Image size 1924x1556. Wide-field retinal mosaic image
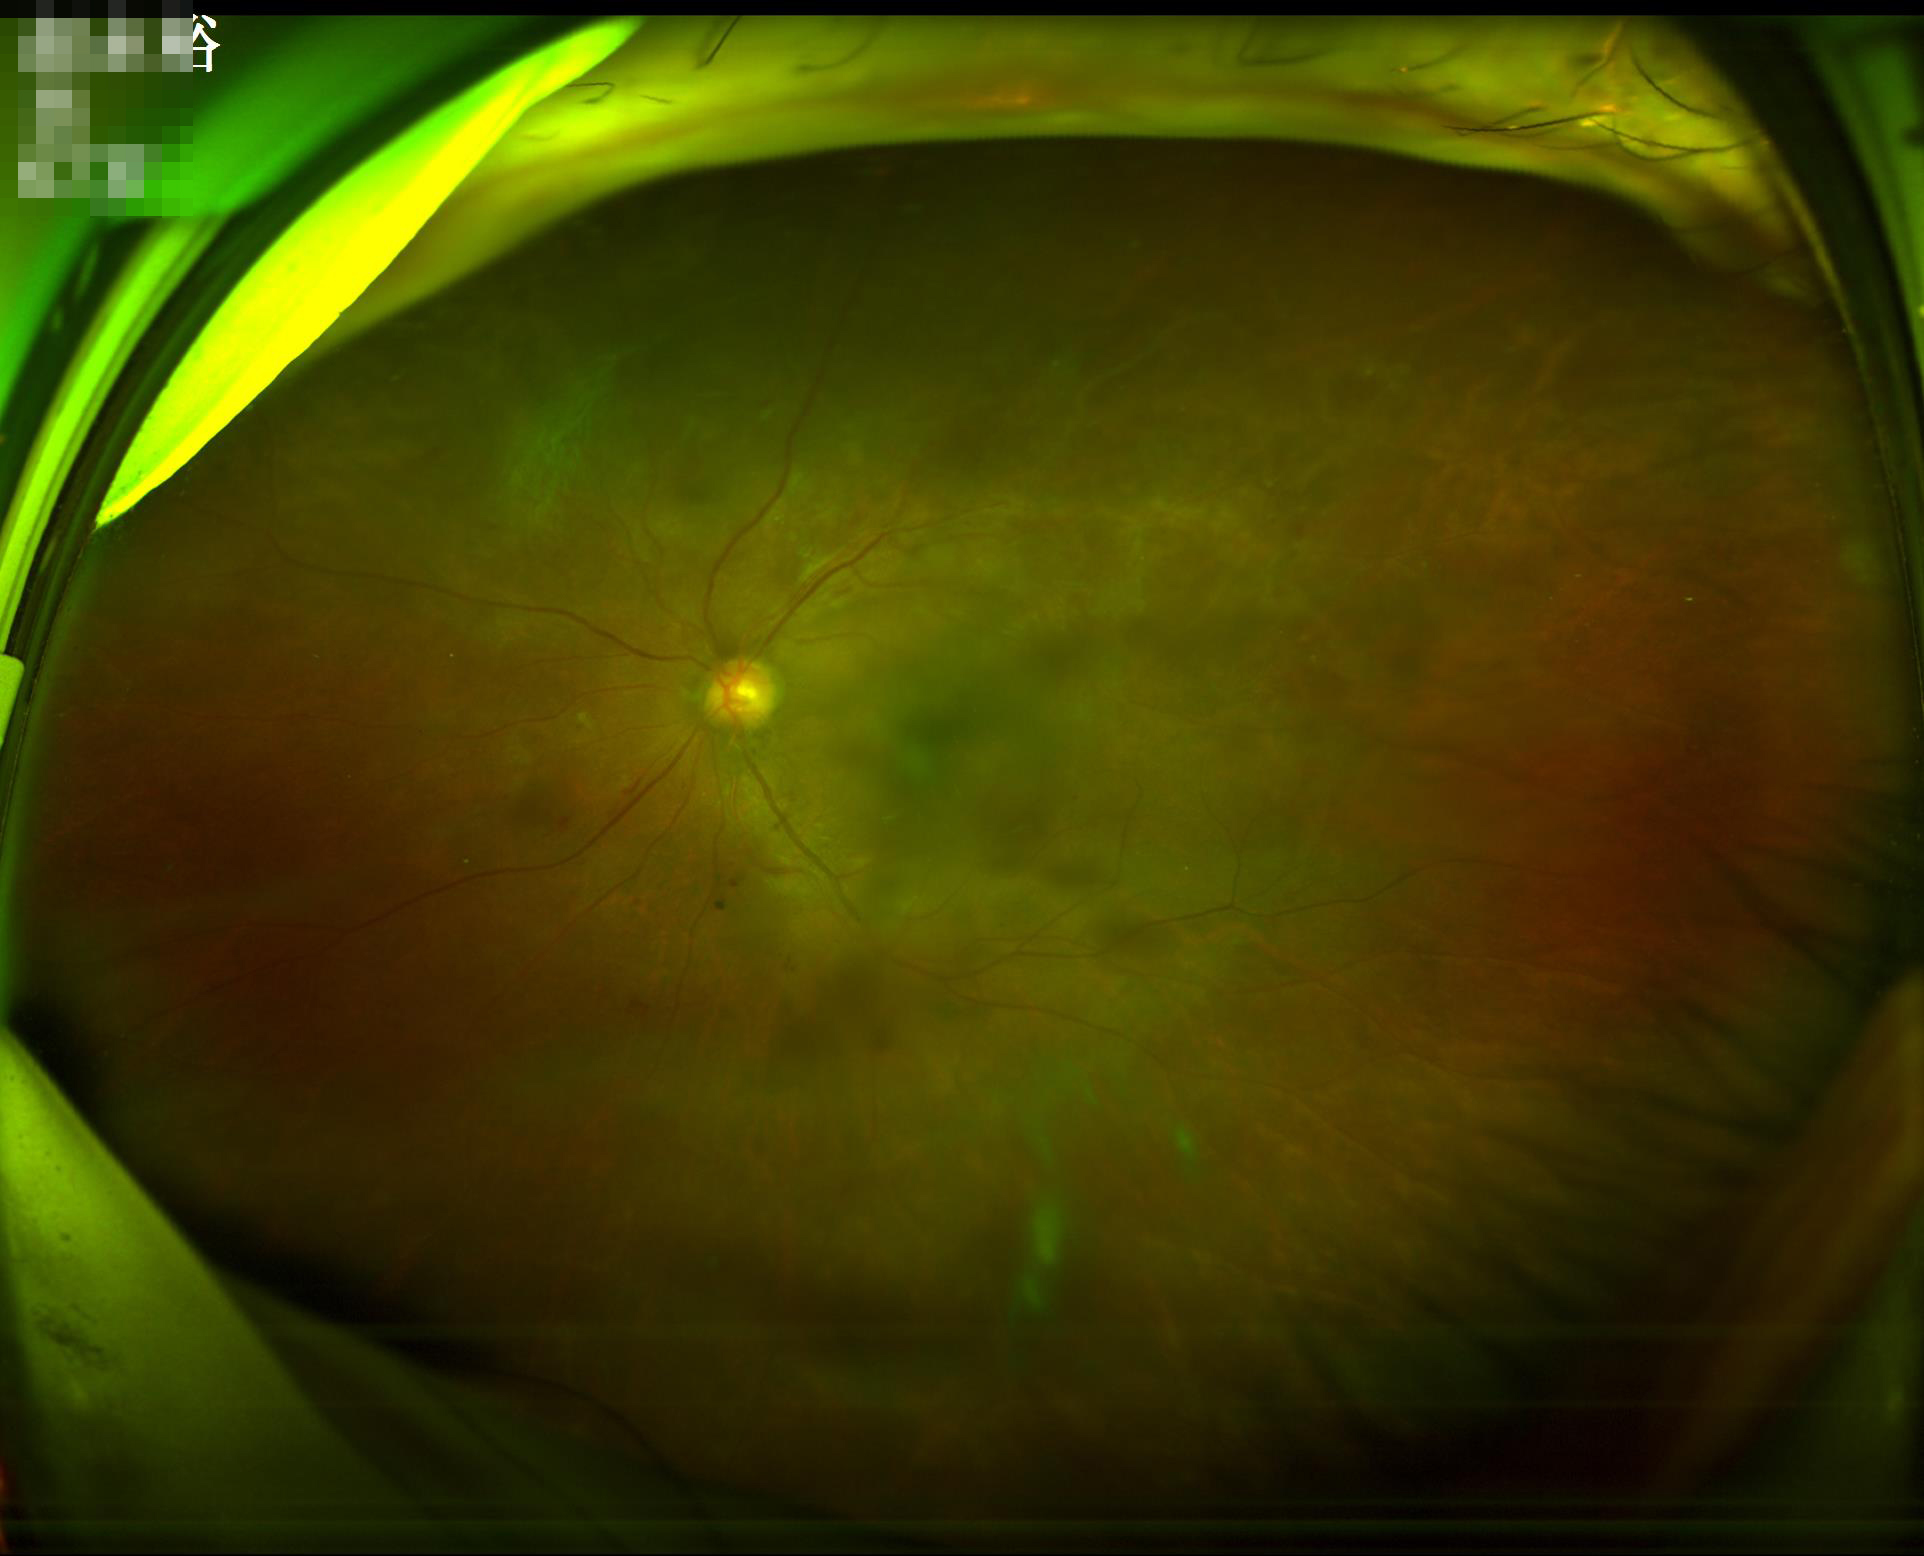

Focus: out of focus, structures indistinct
Illumination/color: no over- or under-exposure
Contrast: vessels and details readily distinguishable
Overall: adequate for clinical interpretation